45-degree field of view. 2352x1568px:
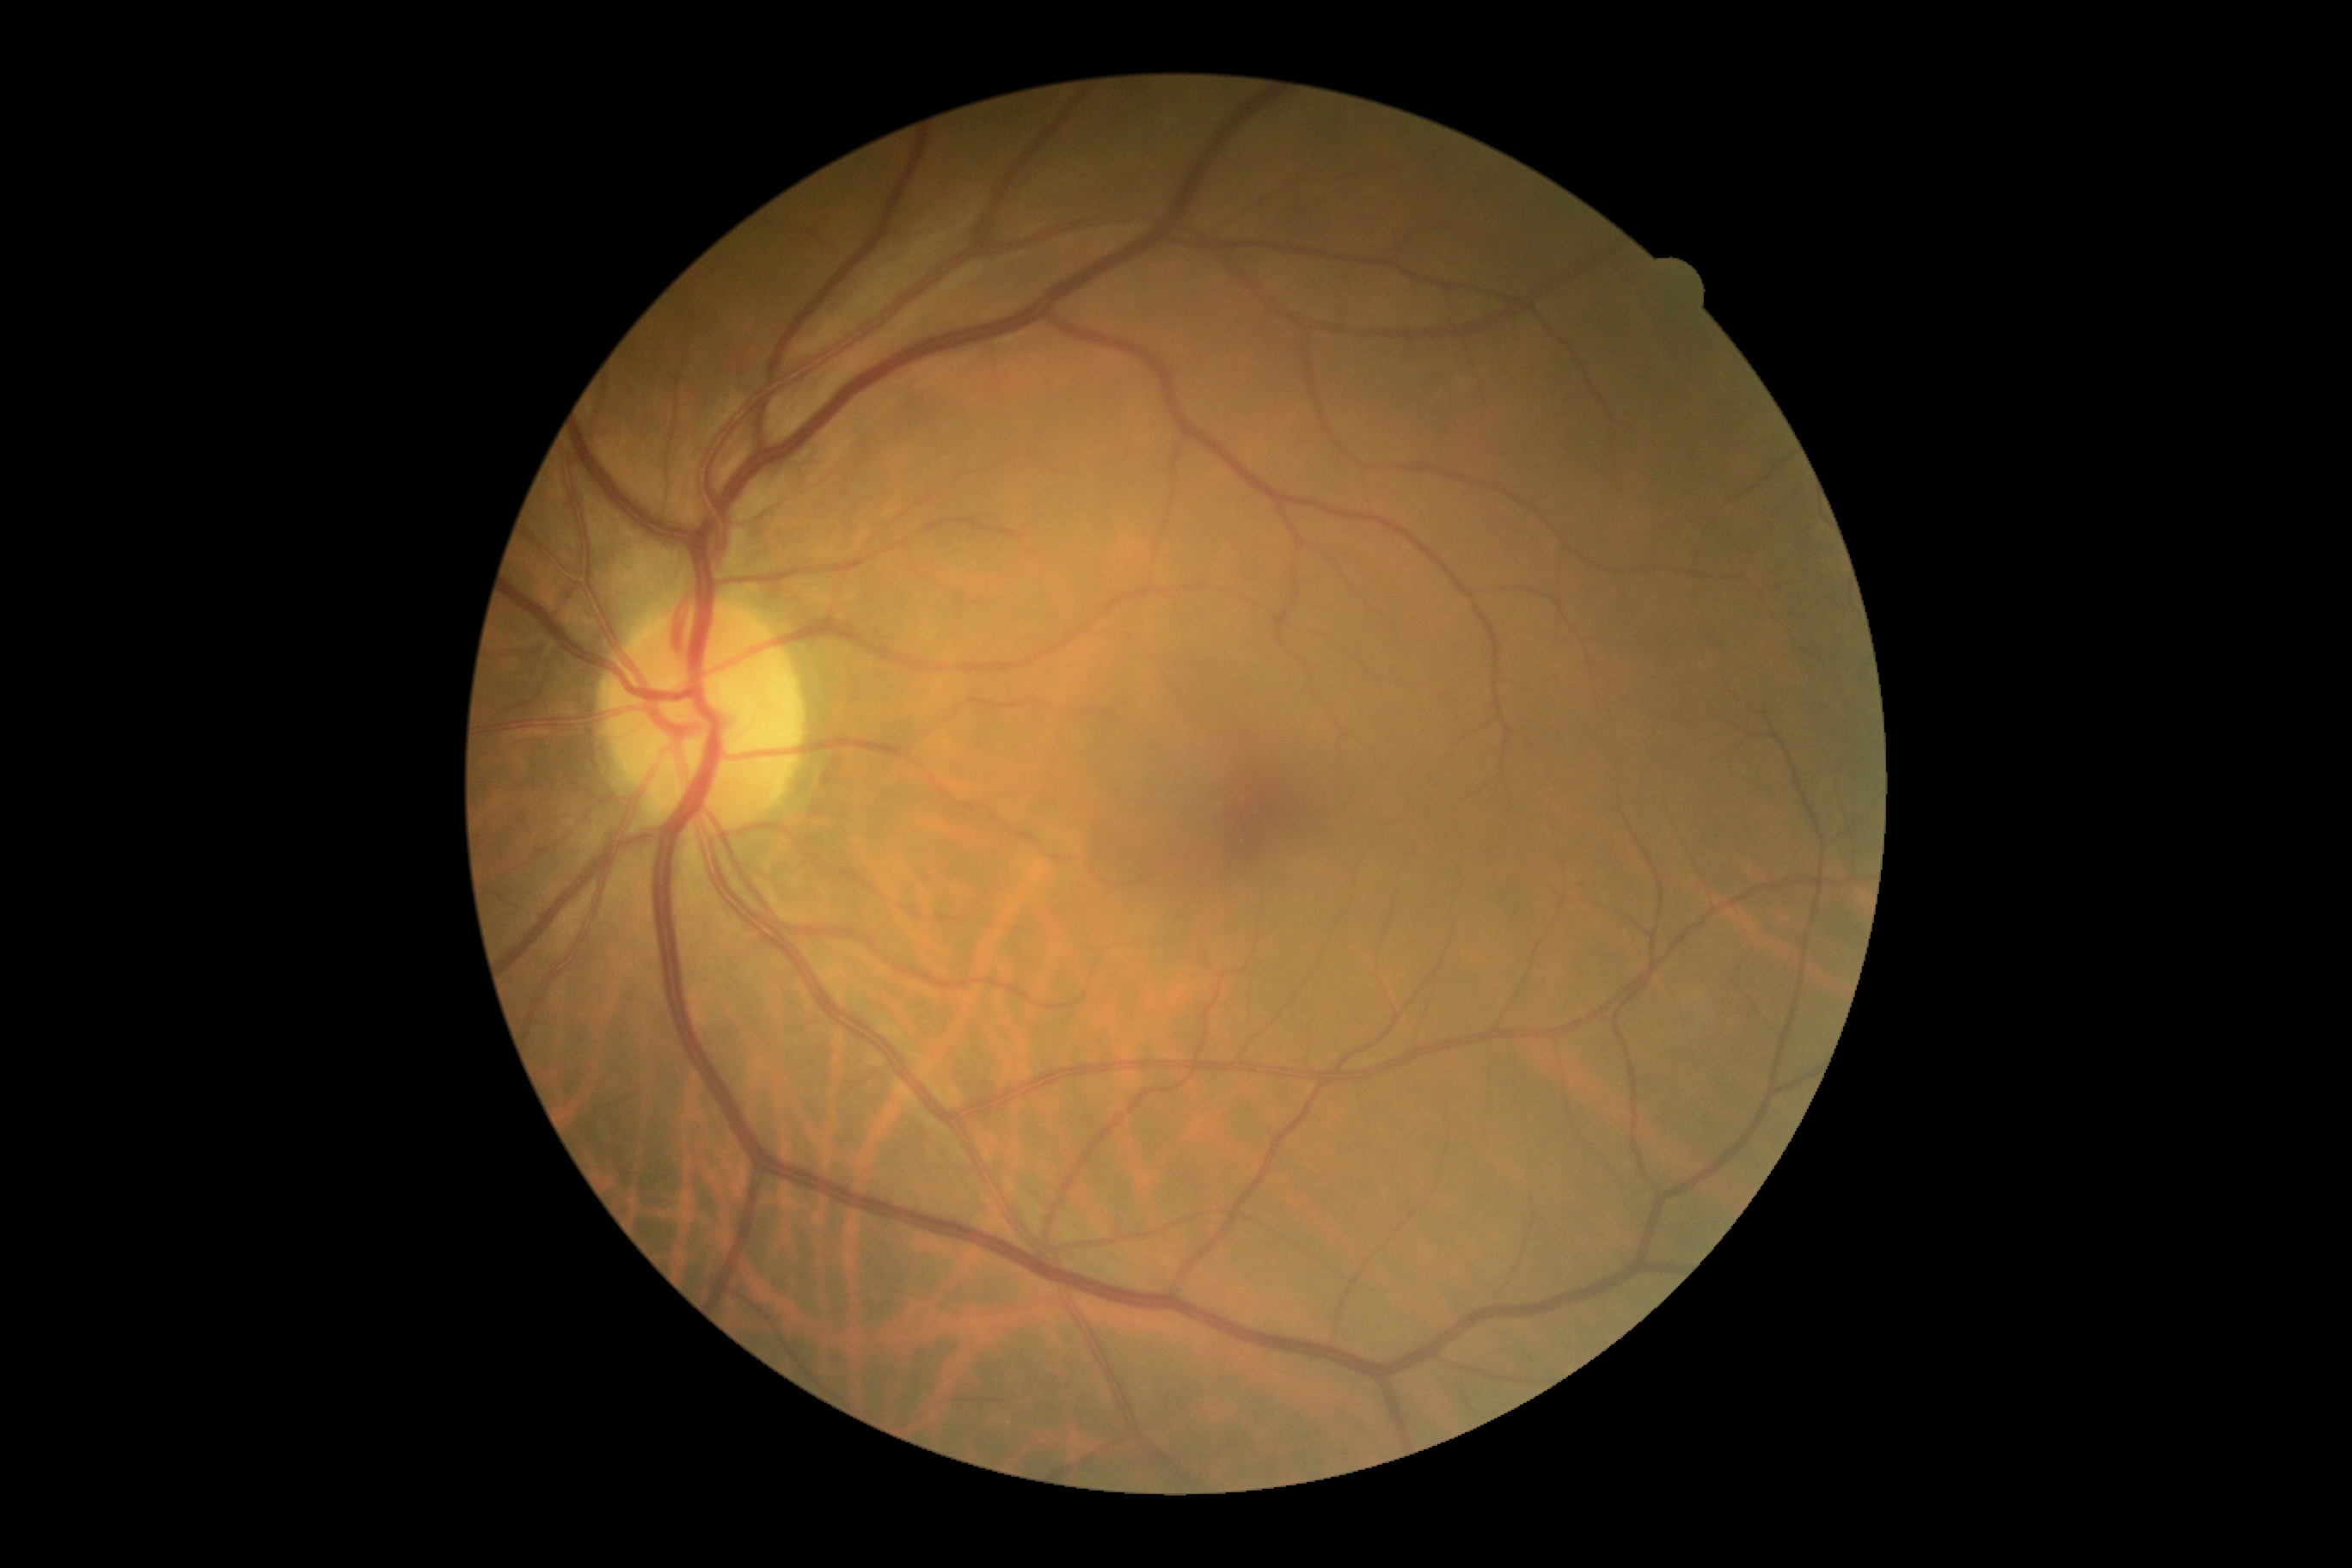 DR stage: grade 0.